1932 x 1932 pixels, CFP, 45-degree field of view: 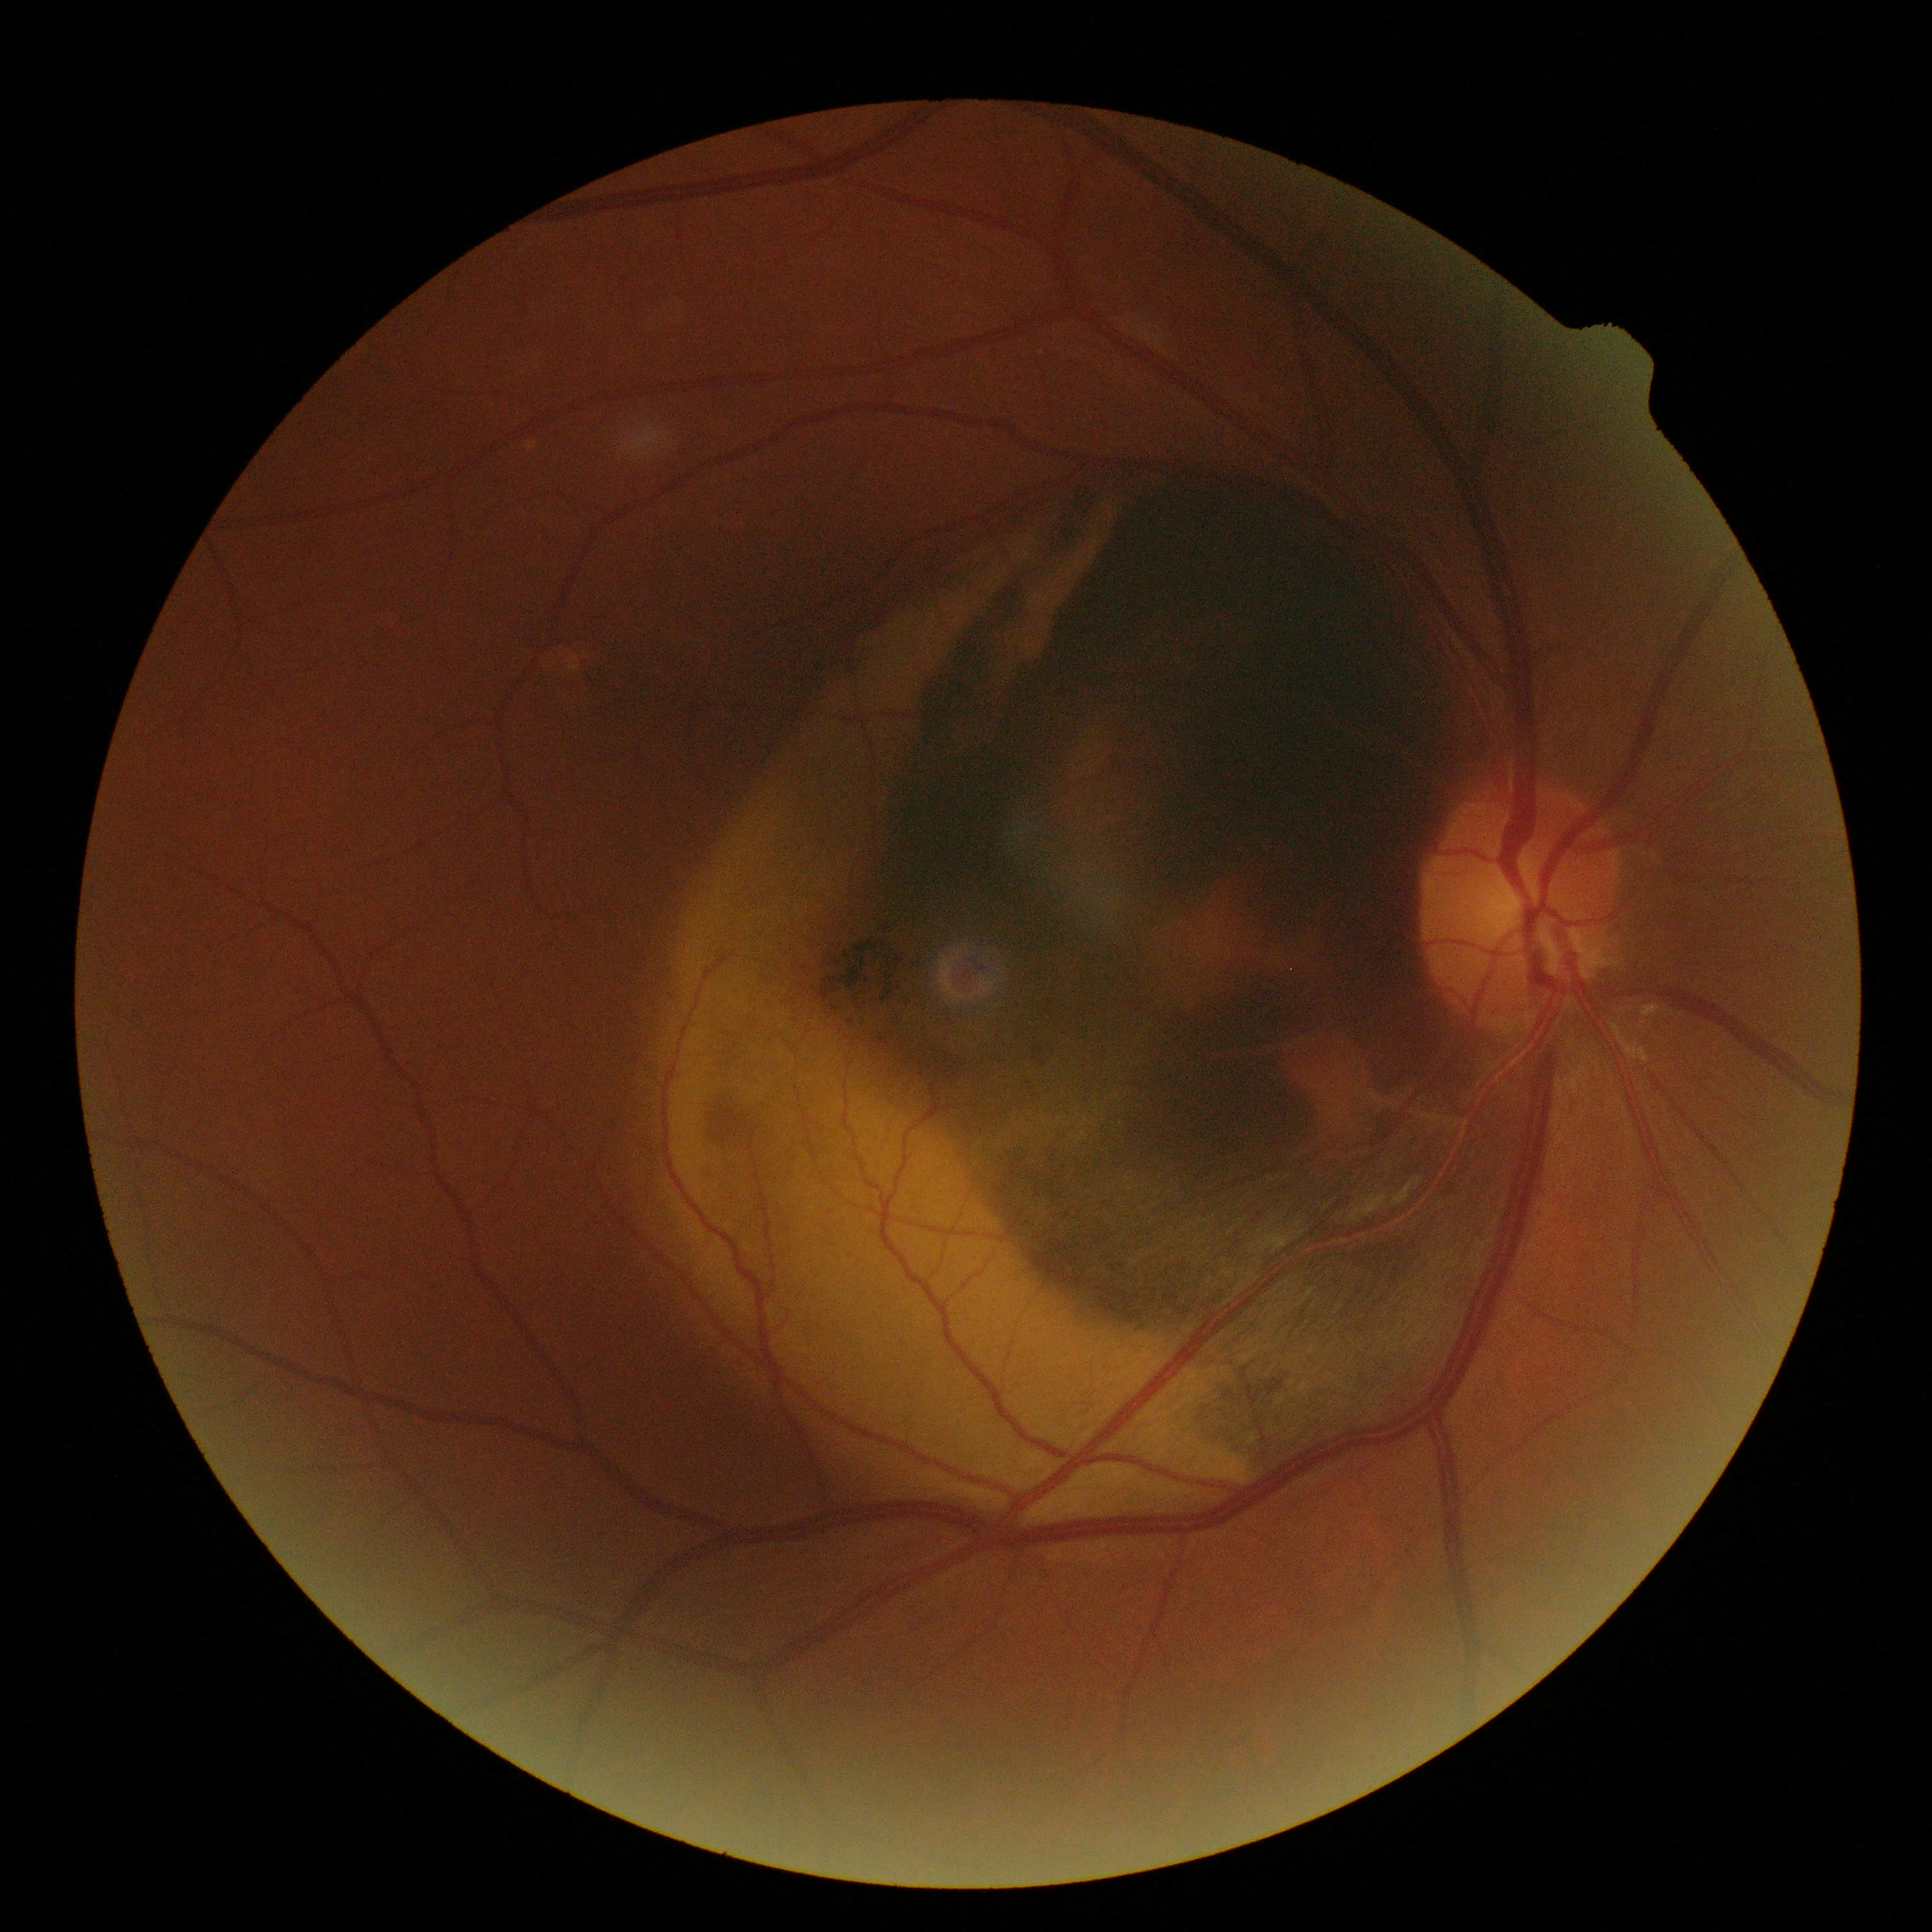
DR grade: 4.